FOV: 50 degrees. Captured after pupil dilation. Macula at the center of the field. Retinal fundus photograph: 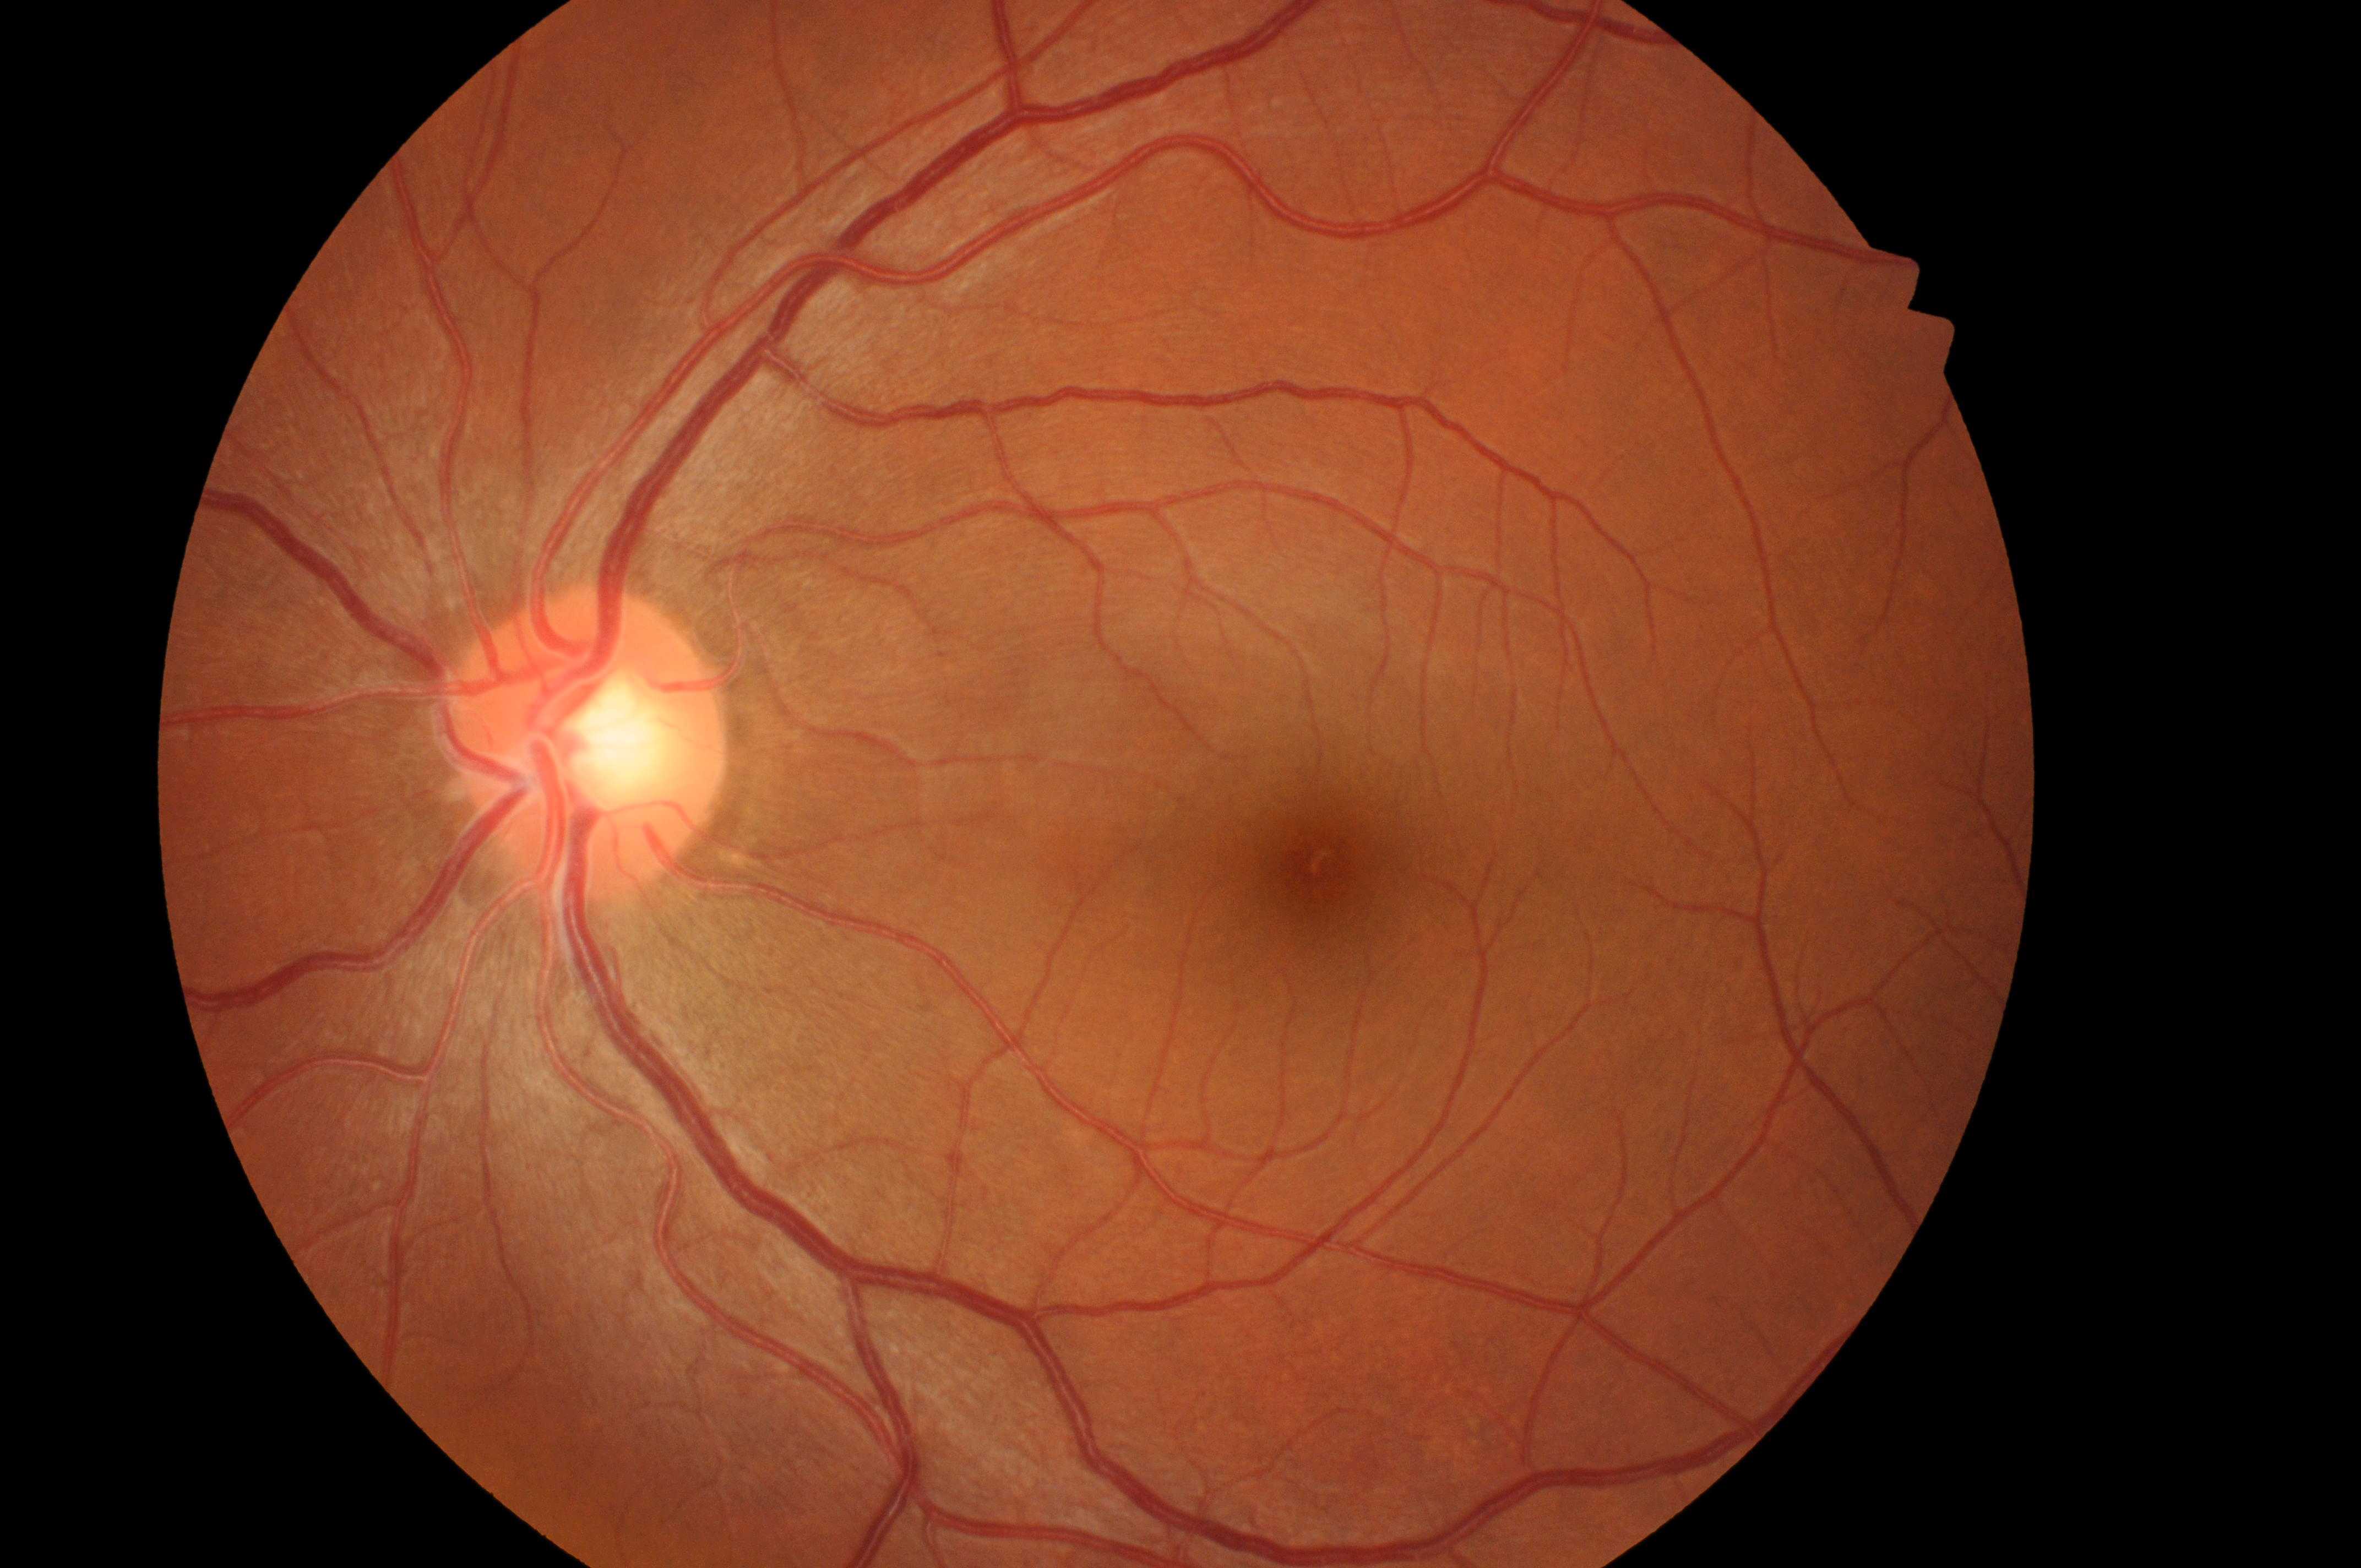 macula center: 1326, 866
diabetic macular edema (DME): no risk (grade 0)
optic nerve head: 587, 756
laterality: left
diabetic retinopathy (DR): grade 0 (no apparent retinopathy)